CFP, 2089 by 1764 pixels
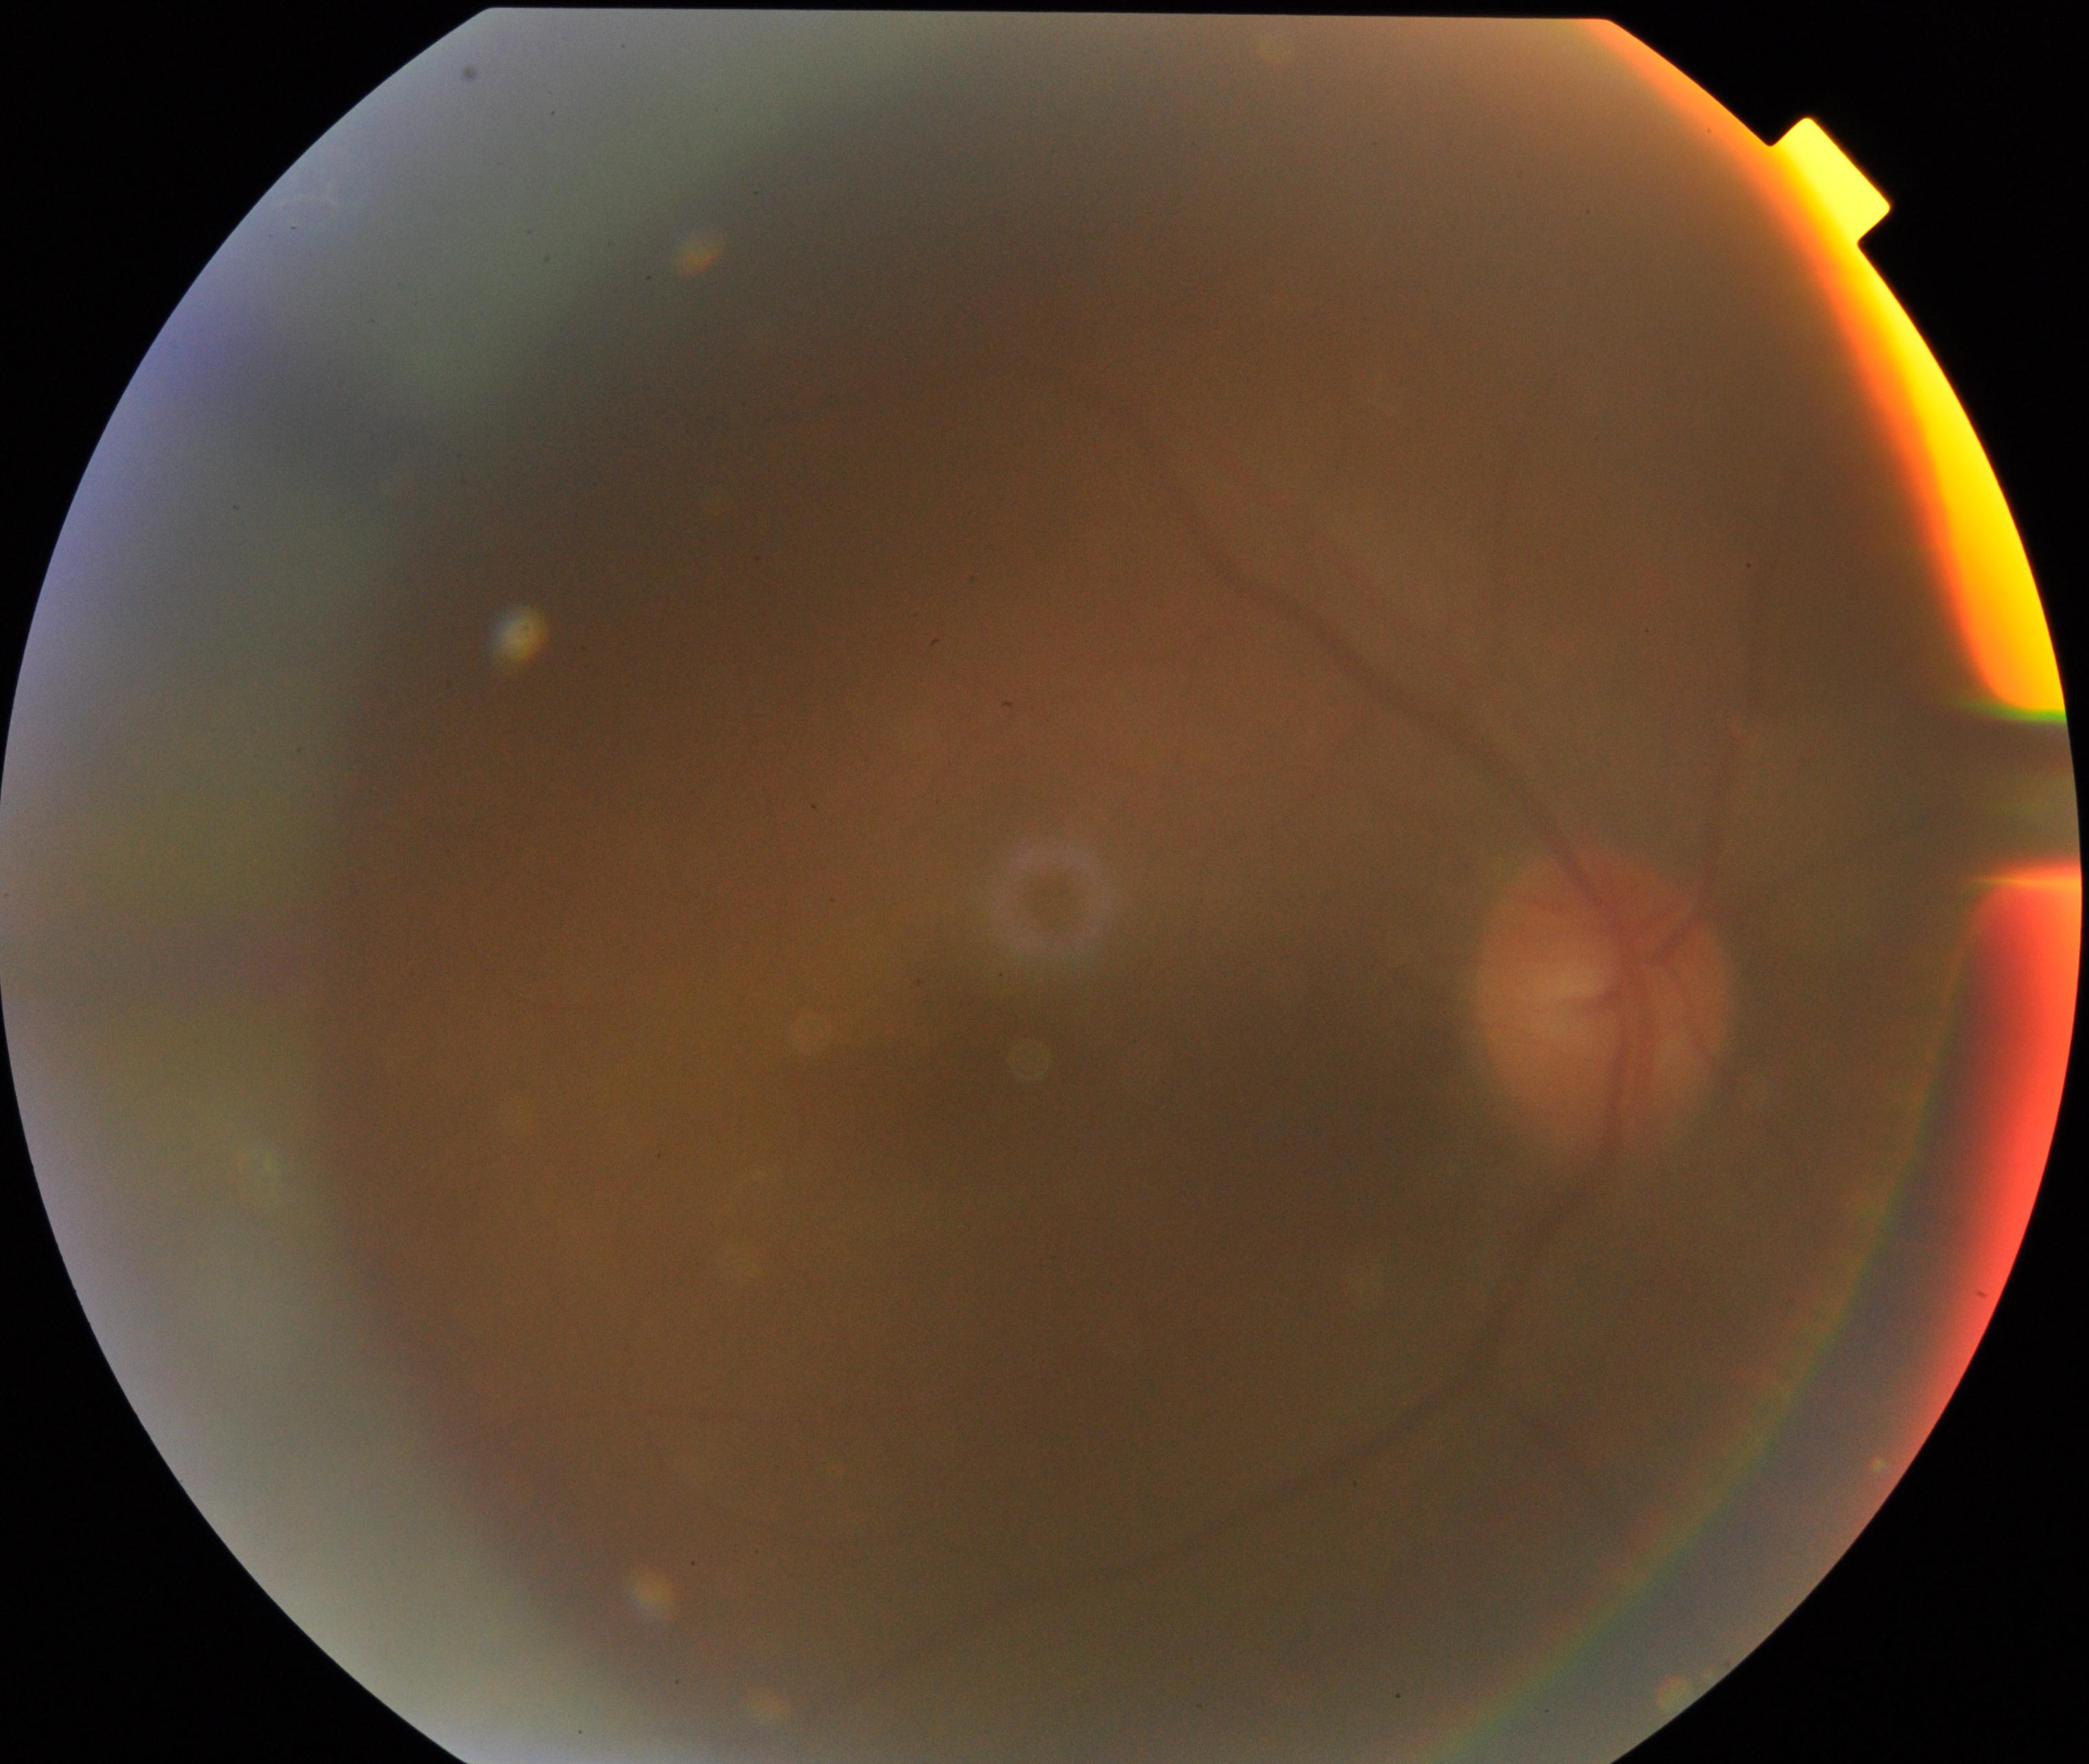

Quality: significantly degraded. Proliferative retinopathy: not identified.